Fundus photo:
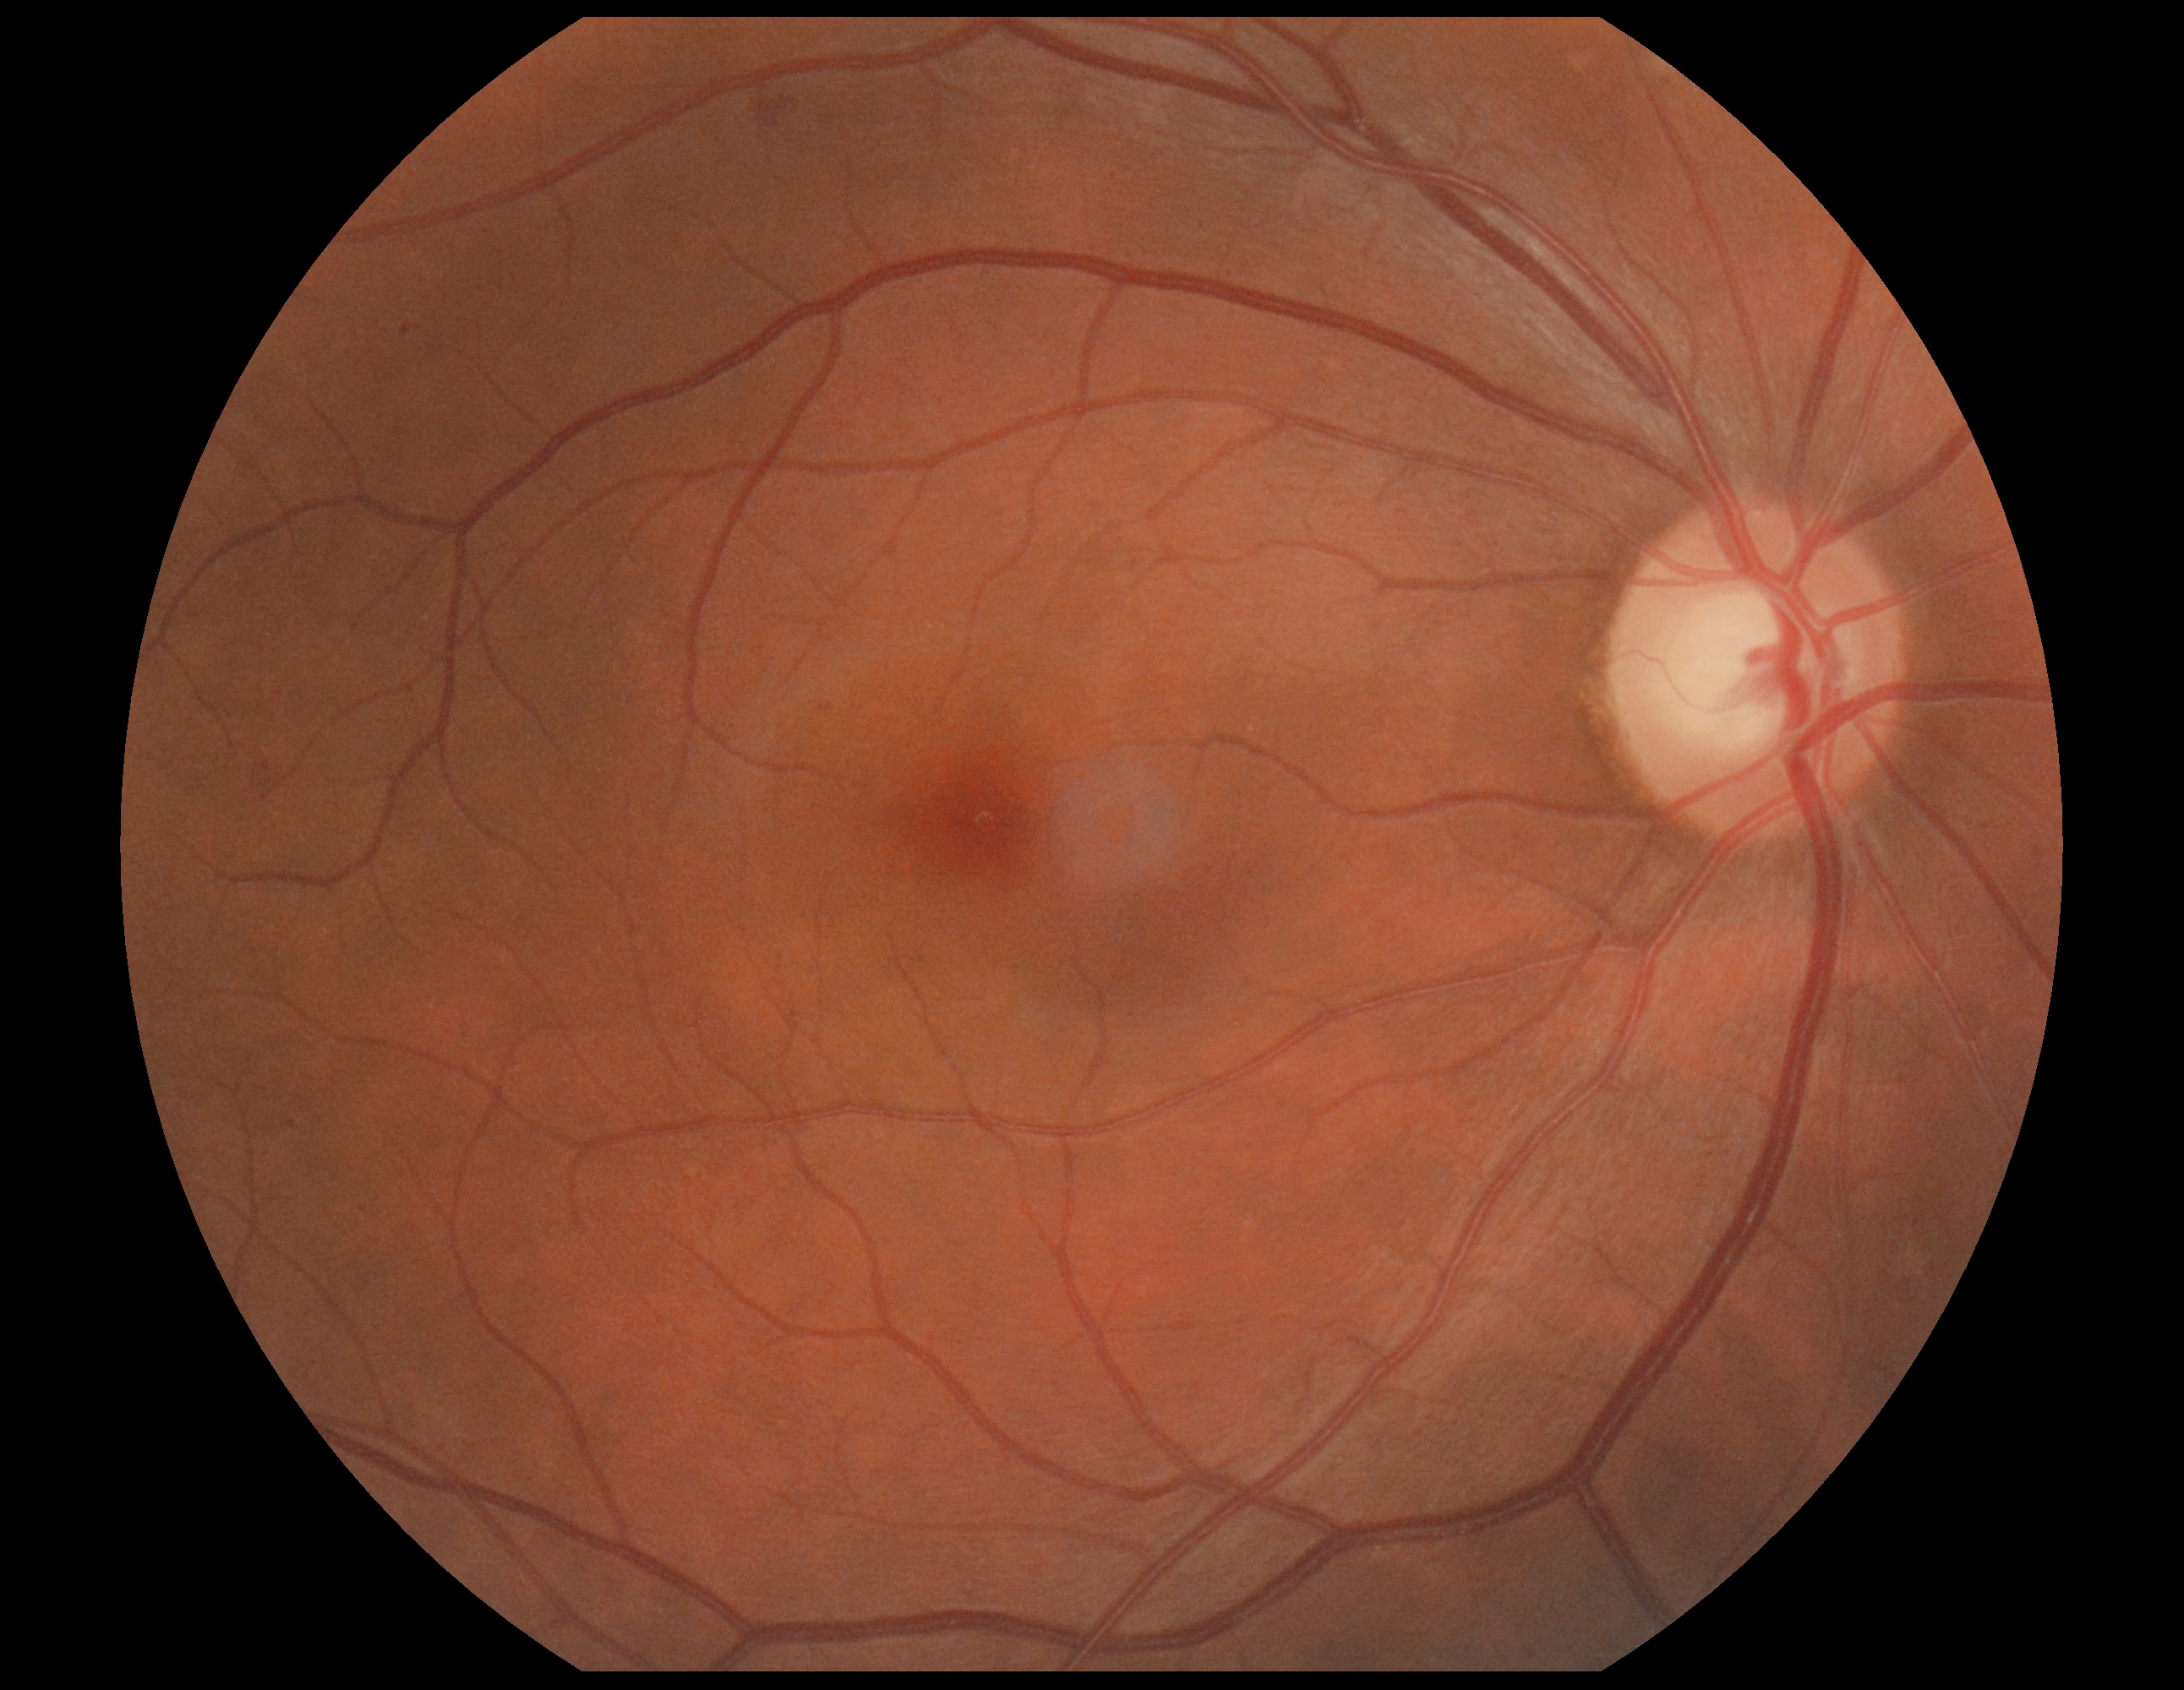

Findings:
* DR severity — 2/4